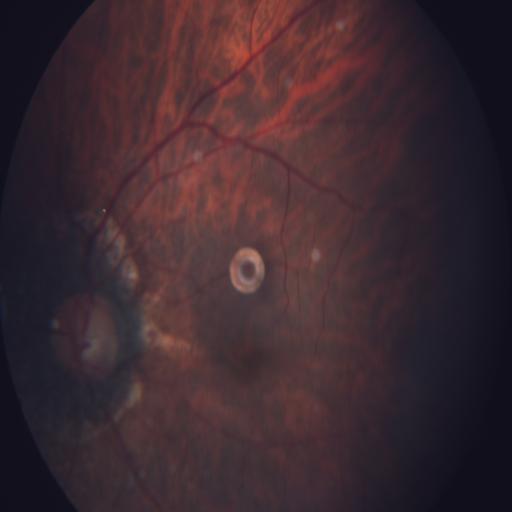

This fundus photograph shows myopia.